CFP — 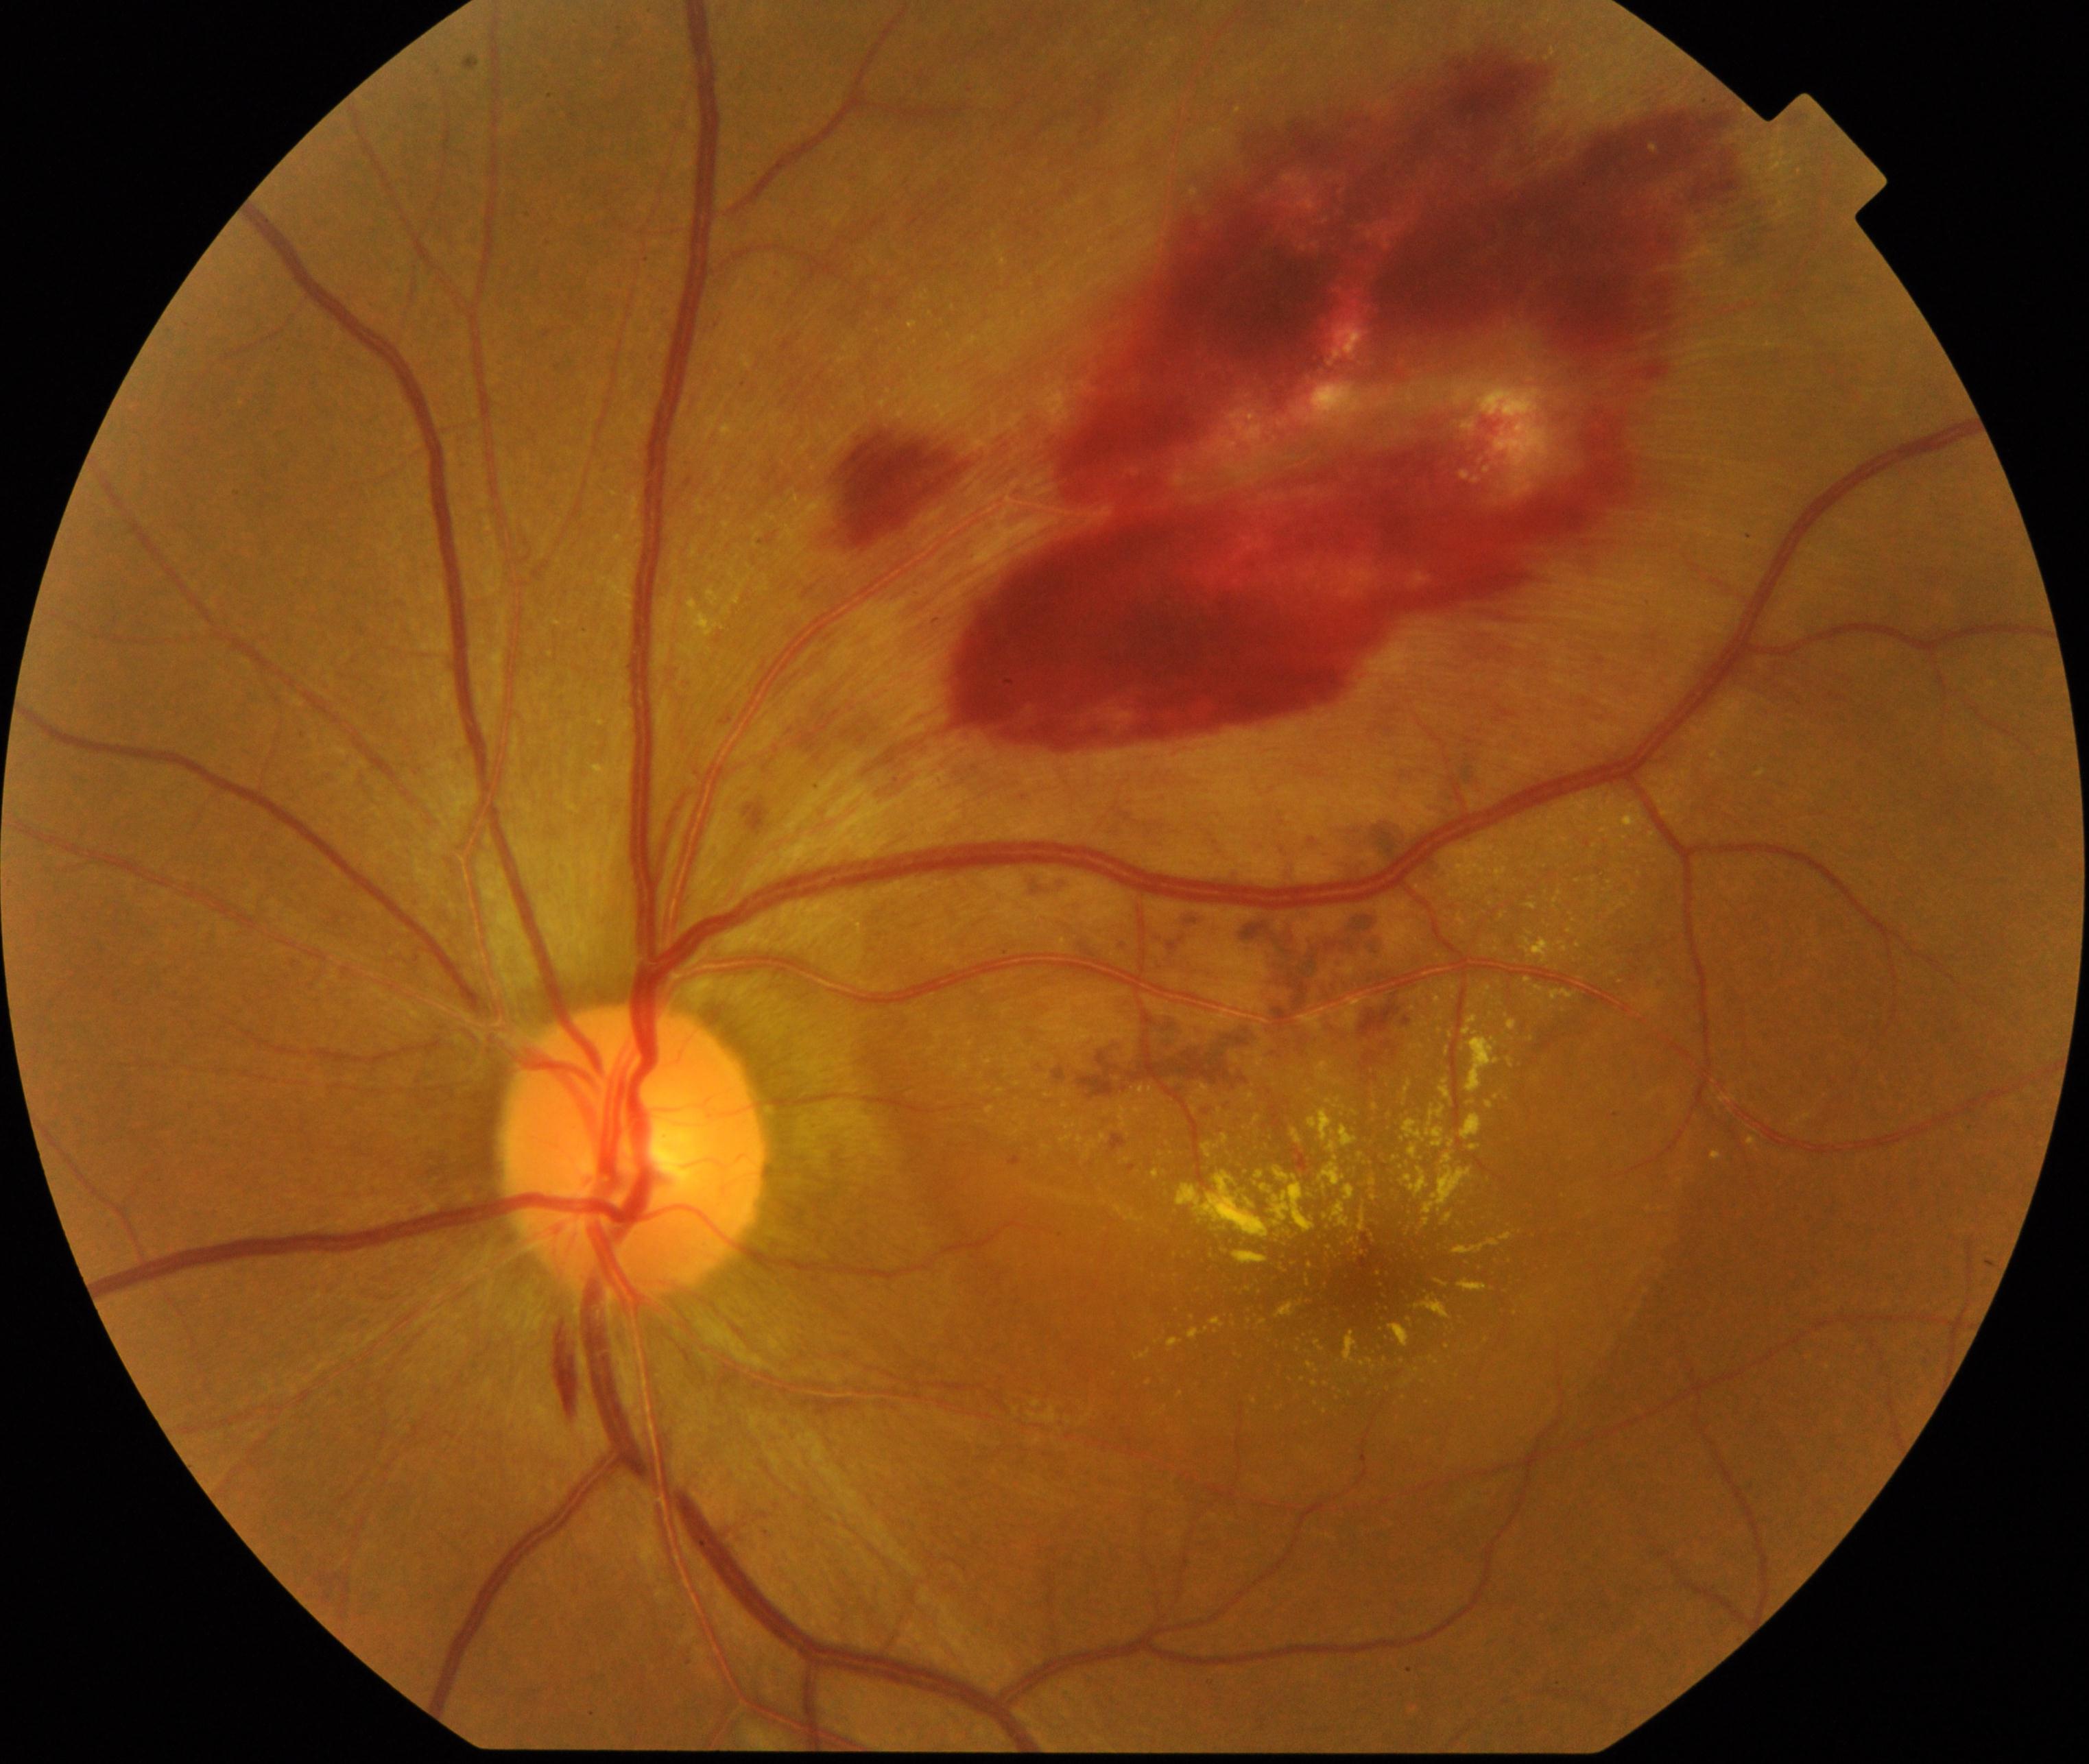

Classification: BRVO (branch retinal vein occlusion). Features include tortuosity and dilatation of affected veins, with dot, blot, and flame hemorrhages, sometimes with cotton-wool spots or hard exudates.